45° field of view · color fundus image: 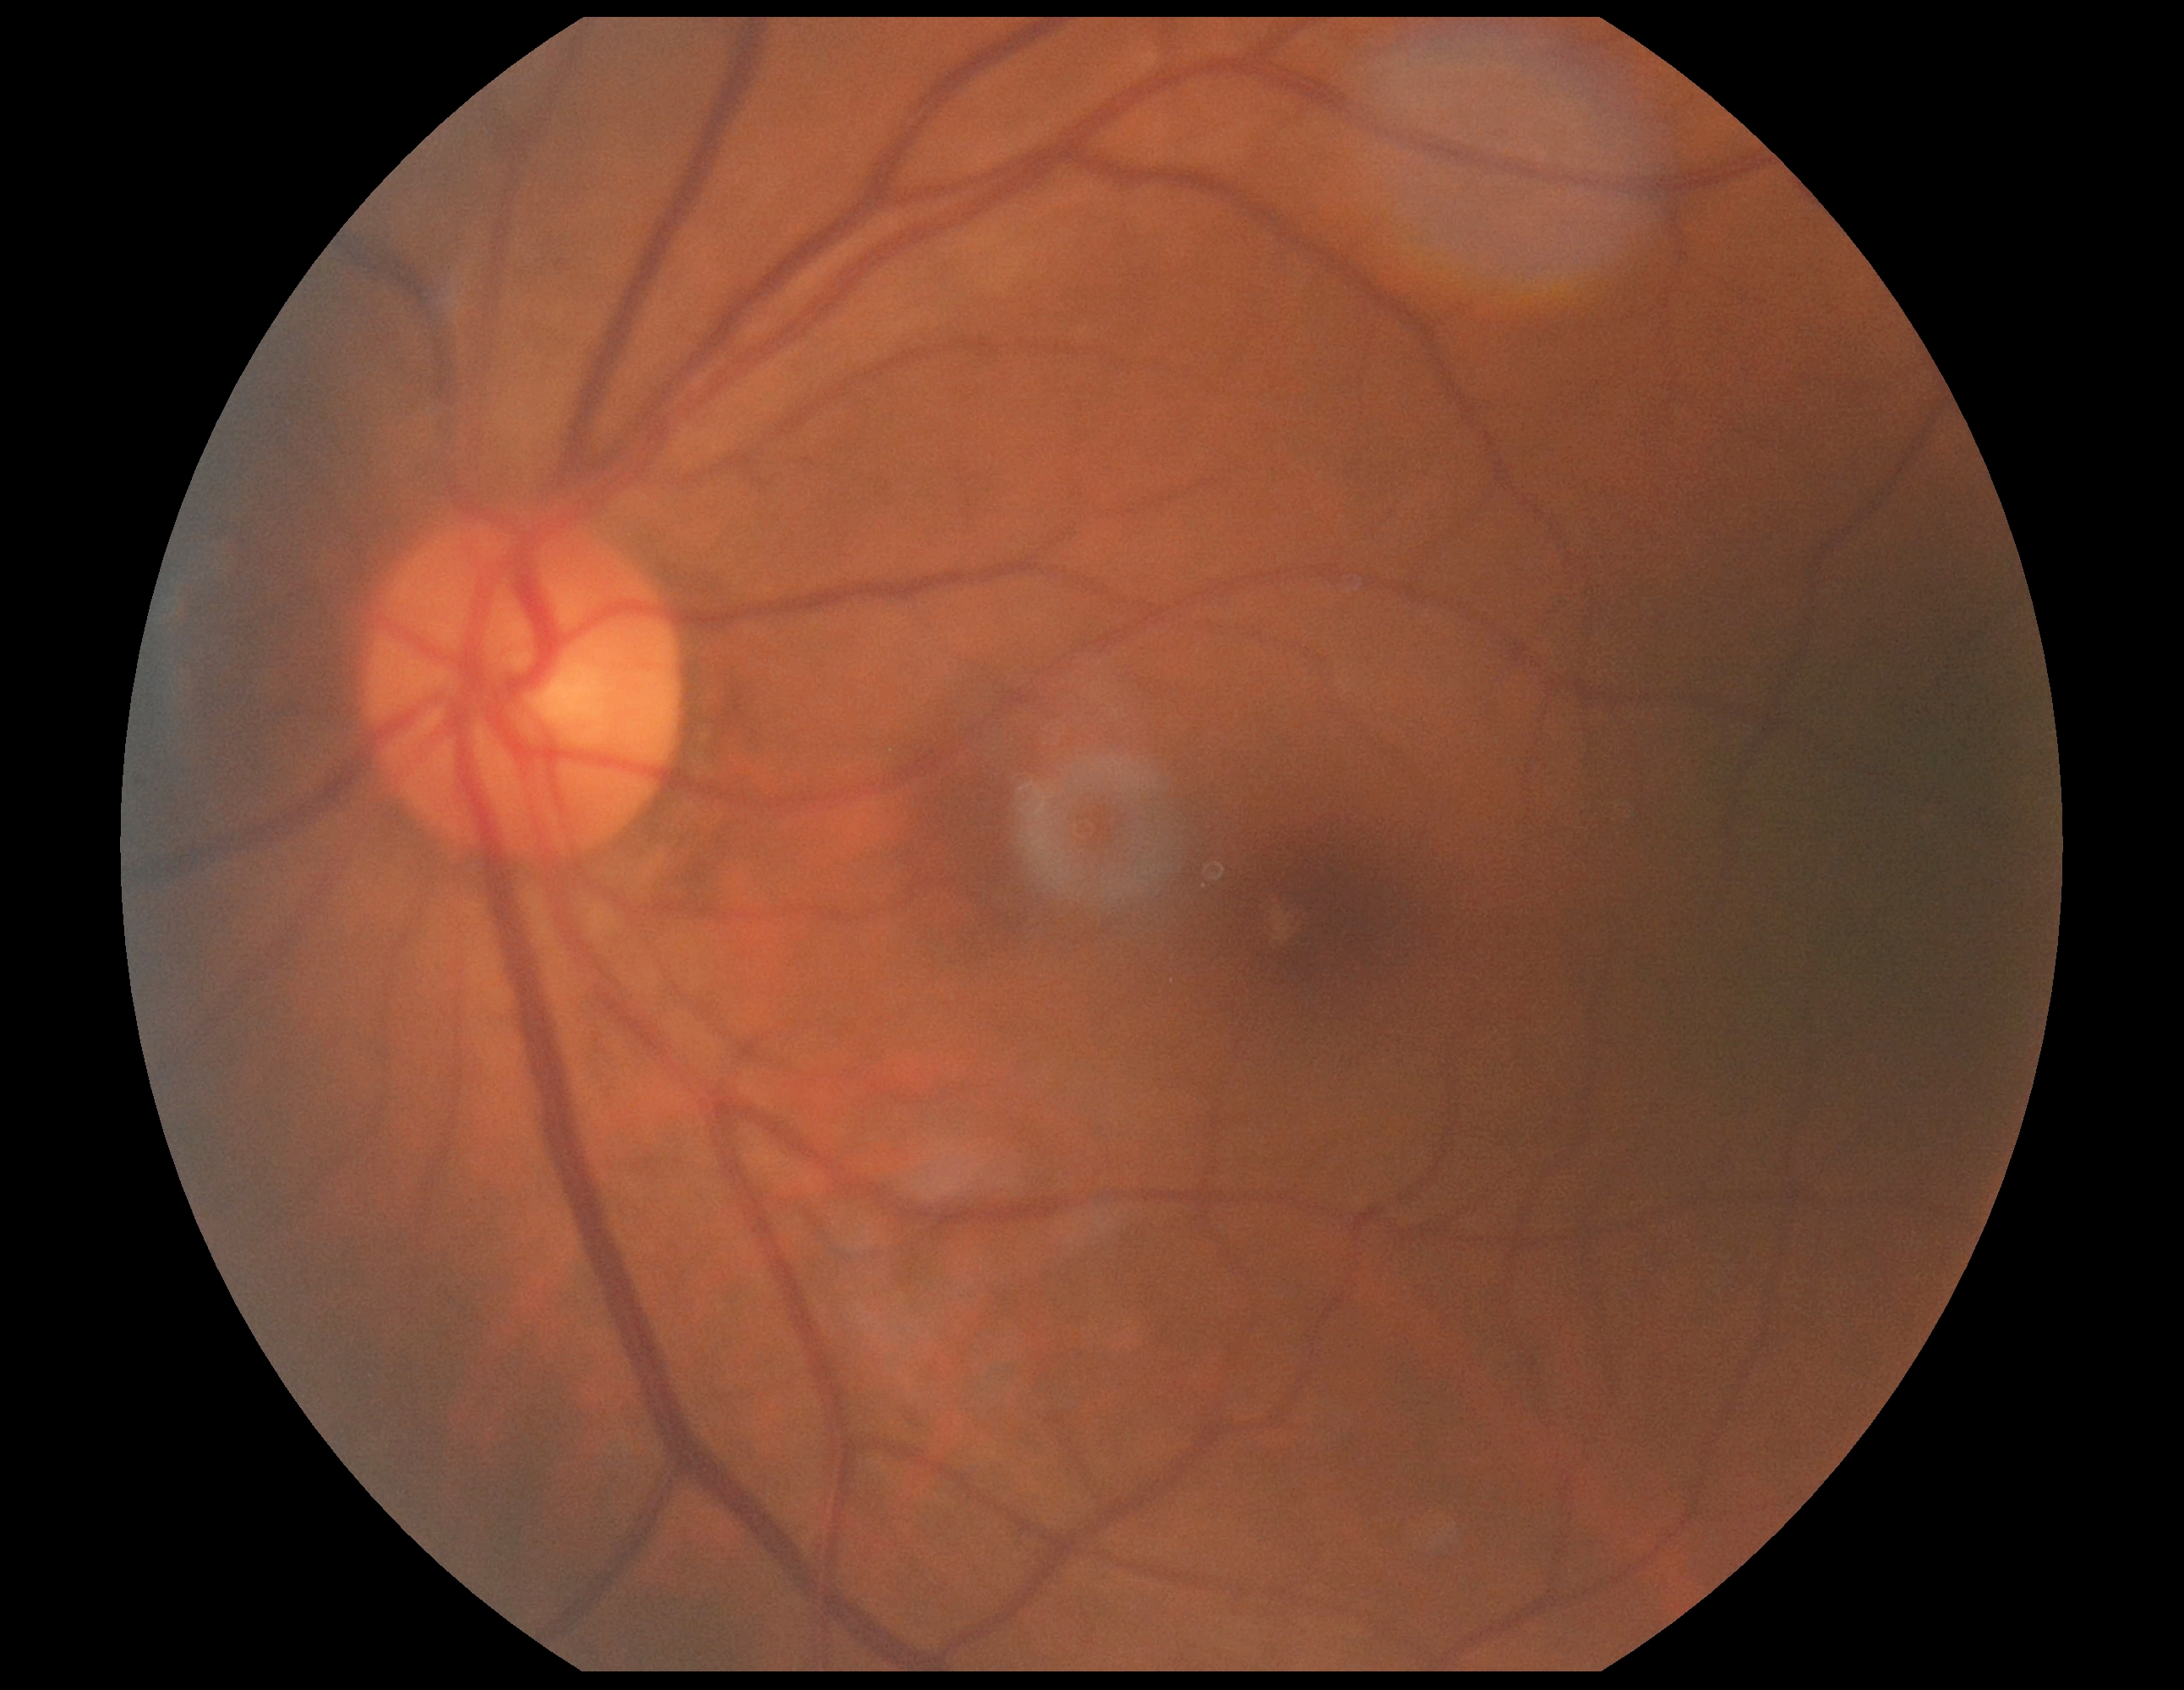

retinopathy grade: no apparent diabetic retinopathy (0)